Color fundus photograph · 45 degree fundus photograph — 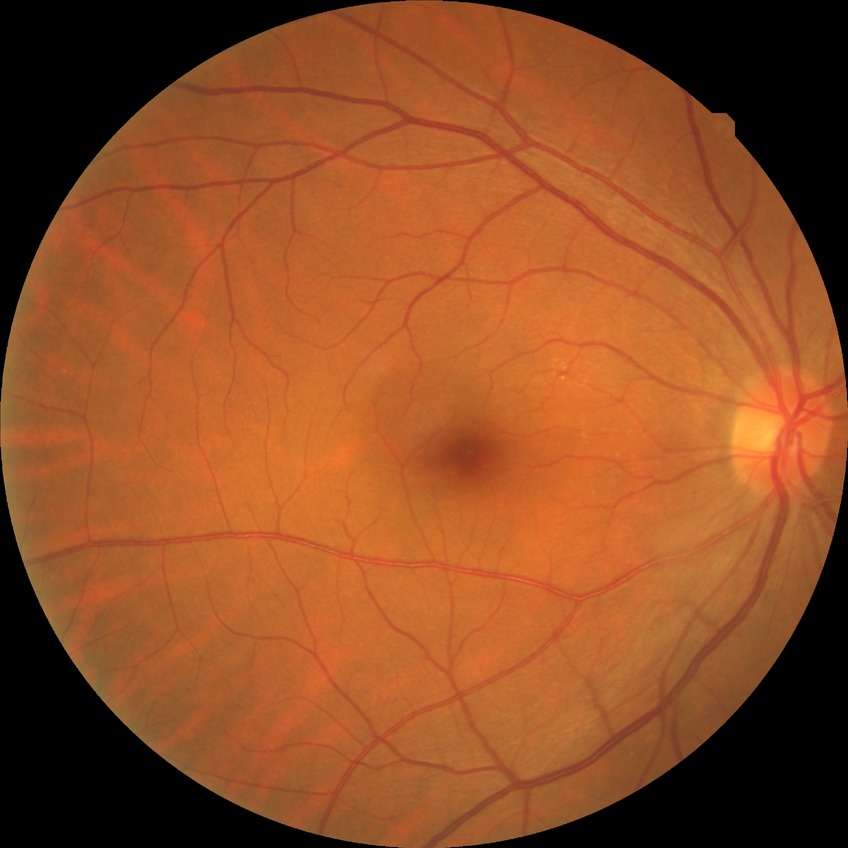

davis_grade: no diabetic retinopathy